CFP
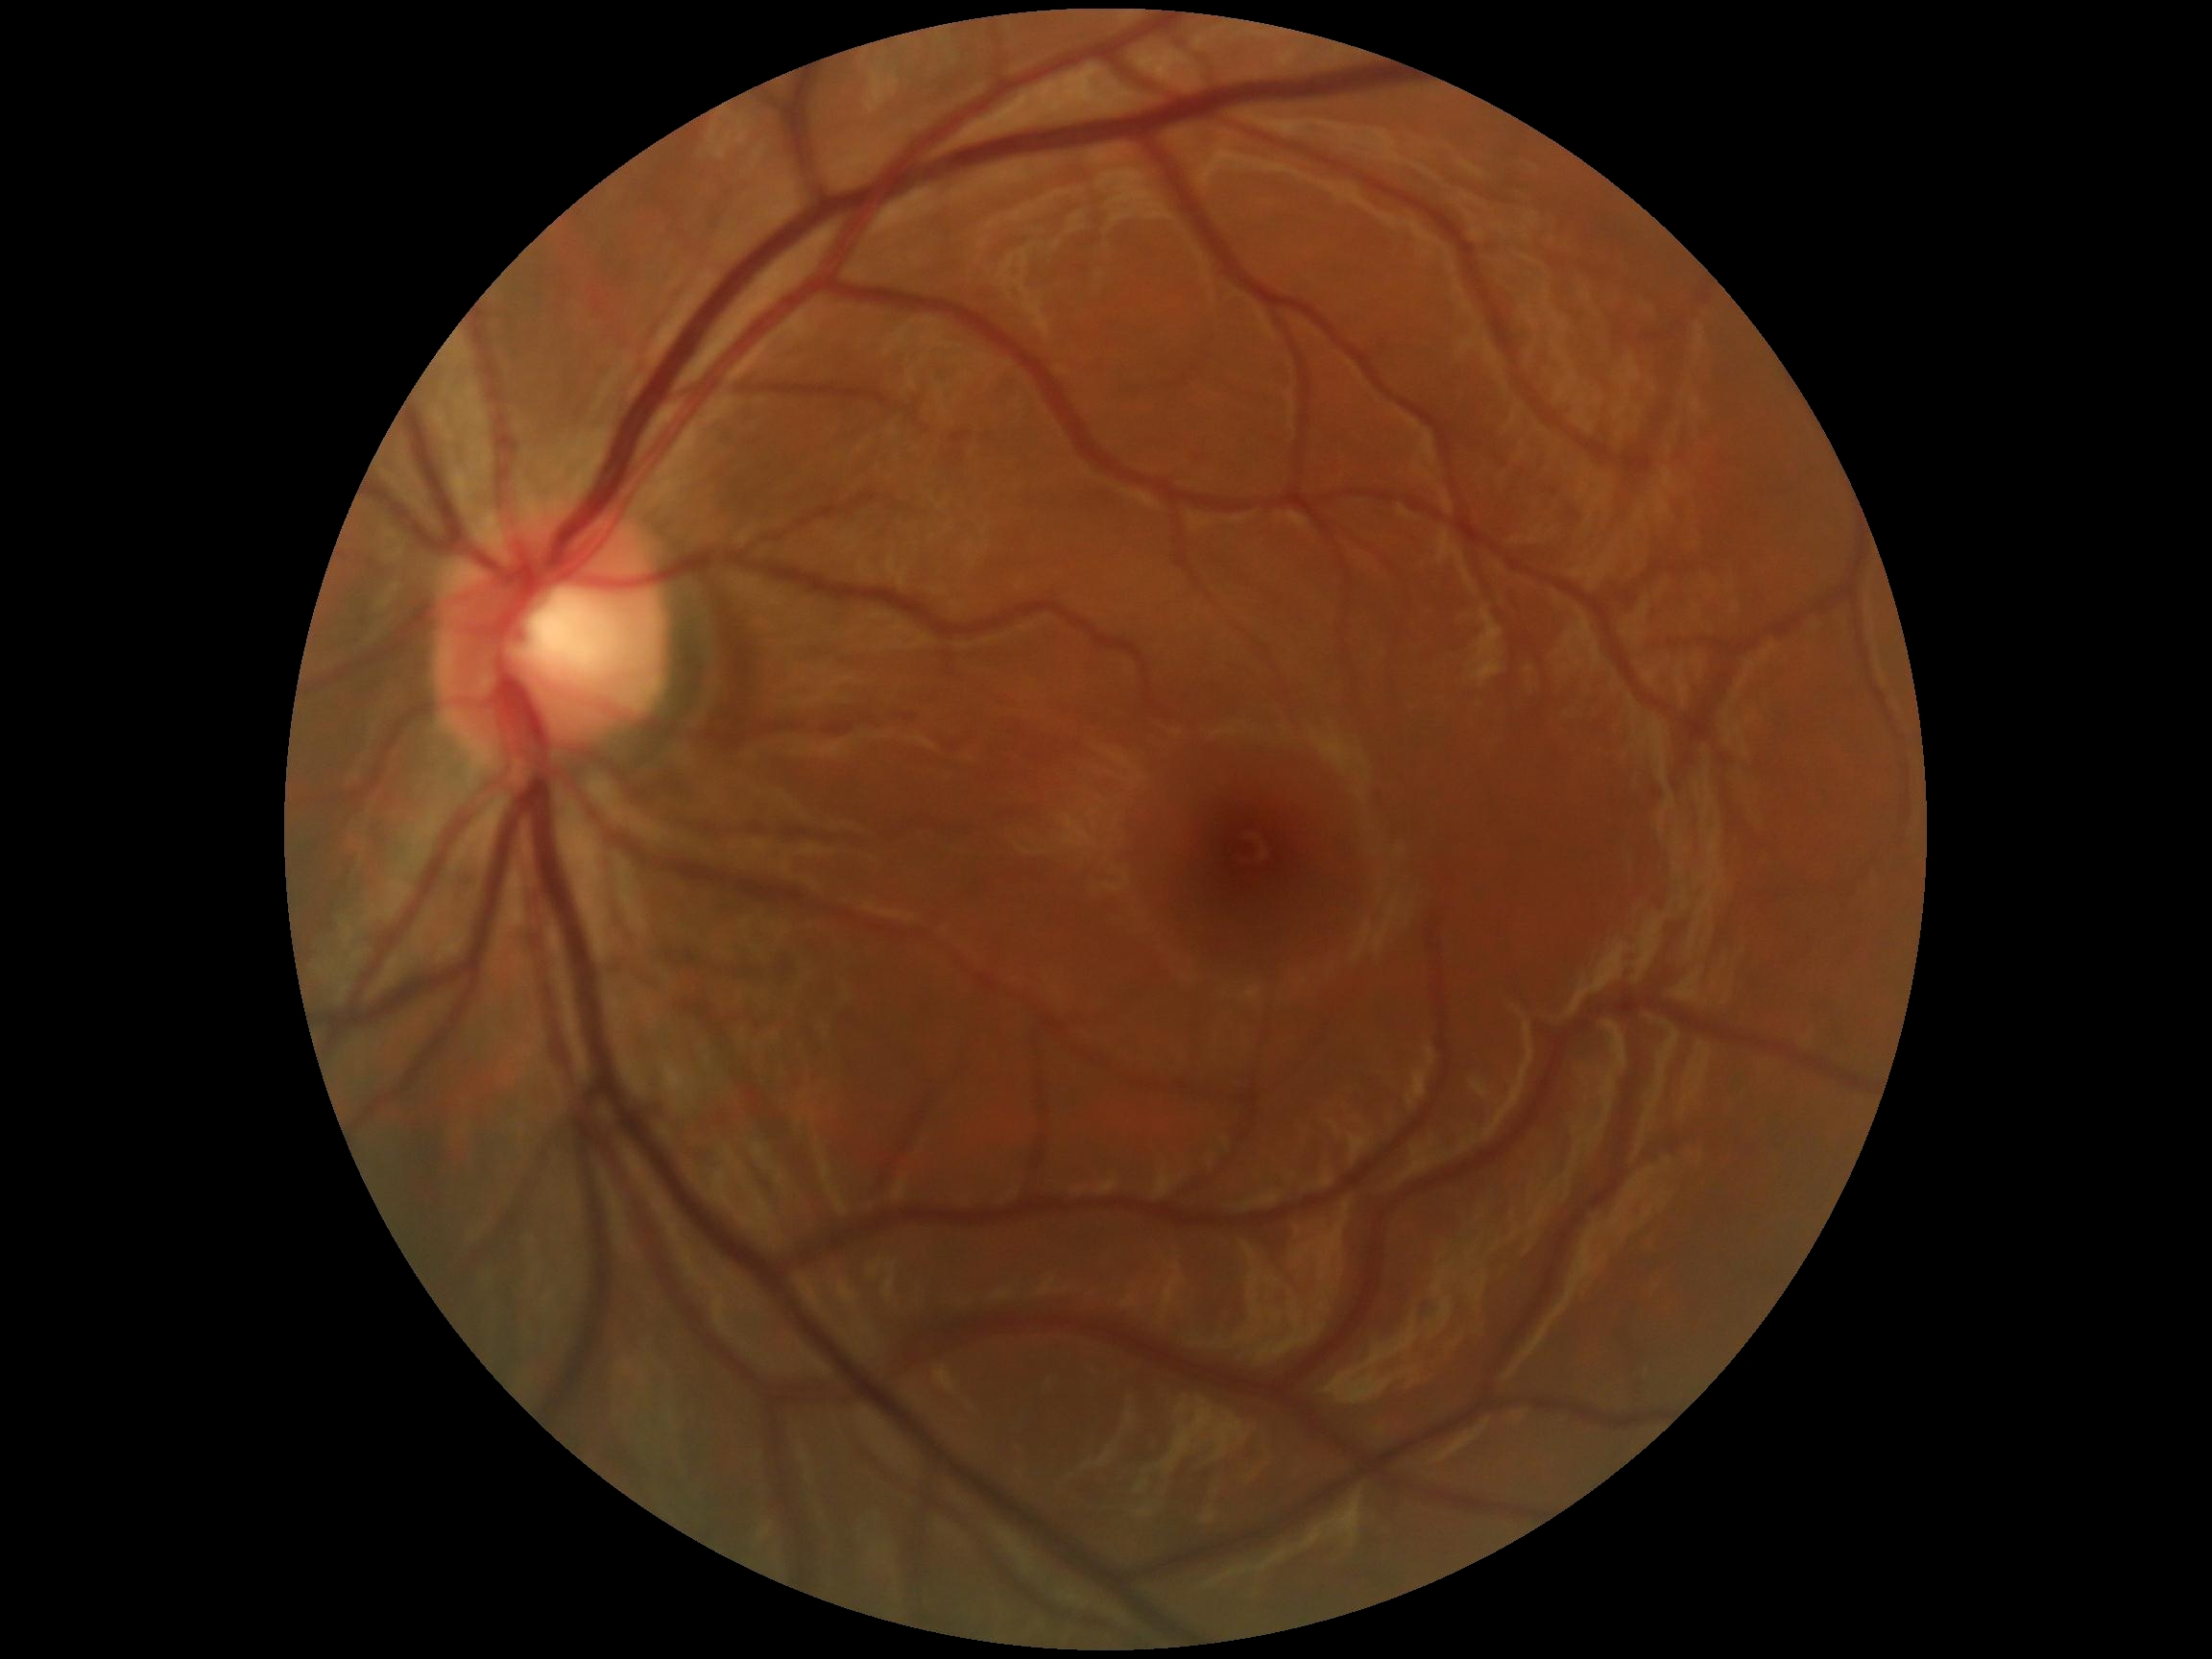 dr_impression: negative for DR
dr_grade: grade 0 (no apparent retinopathy)